1240x1240px · infant wide-field fundus photograph
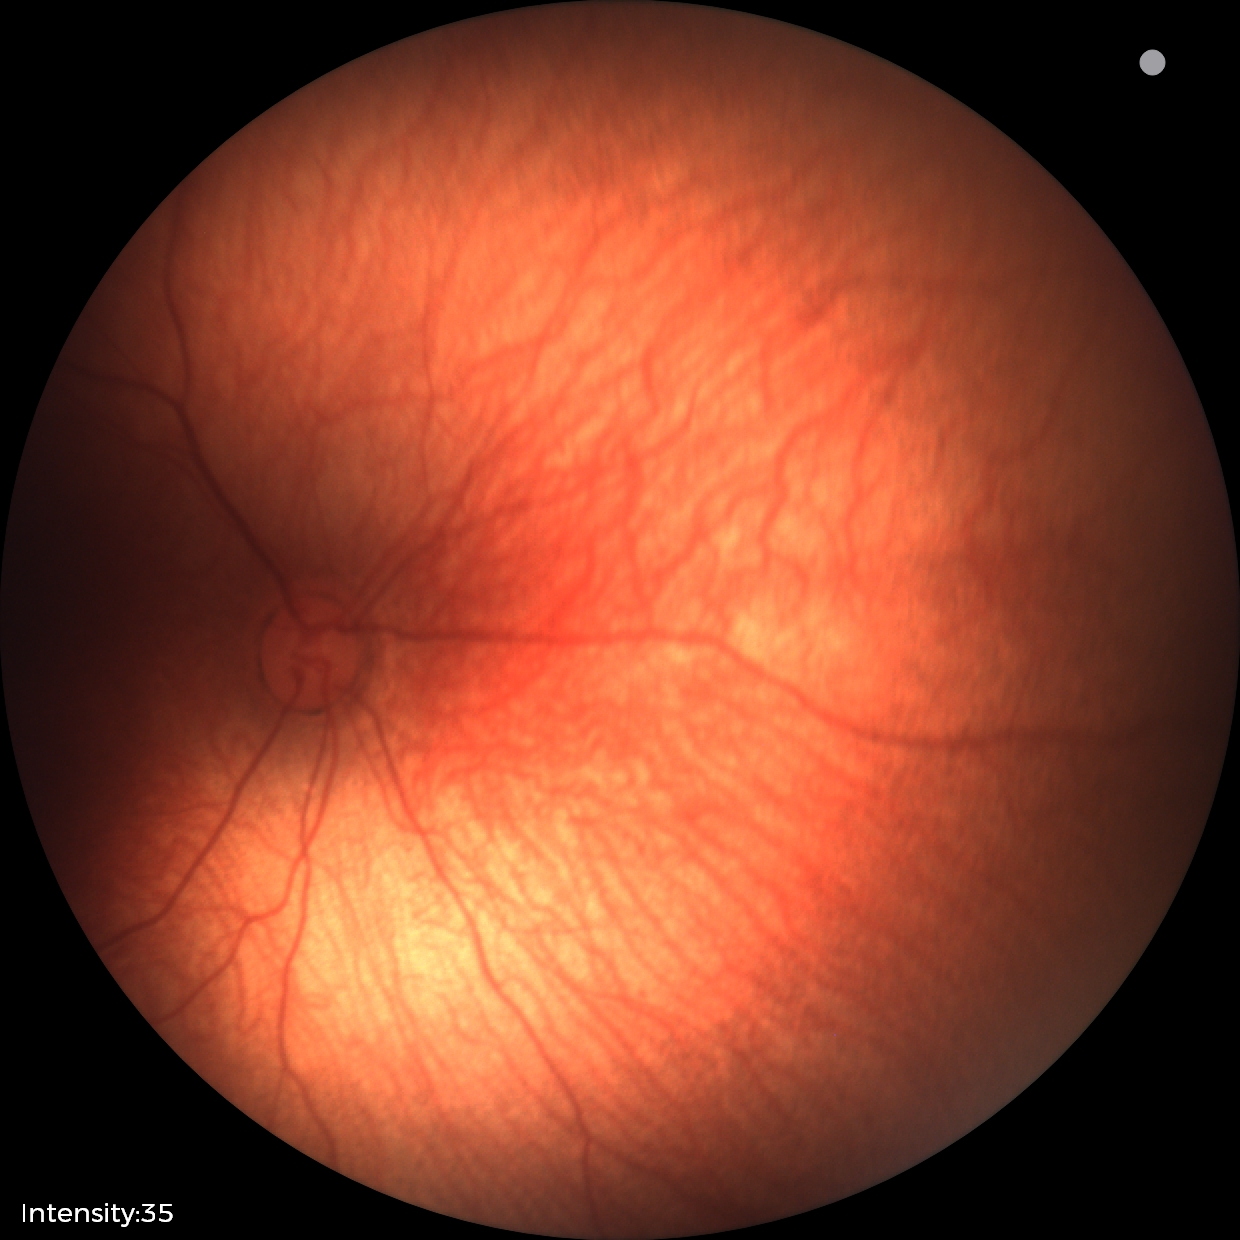
Screening: no abnormal retinal findings.